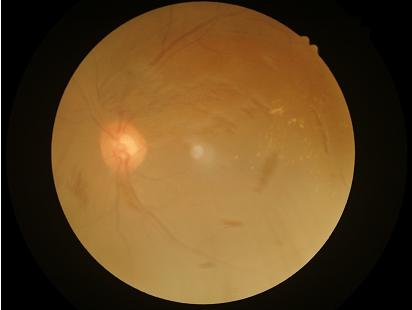
Contrast = low | Focus = reduced | Overall quality = low | Illumination = poor.